848 by 848 pixels. Davis DR grading. No pharmacologic dilation. 45° field of view — 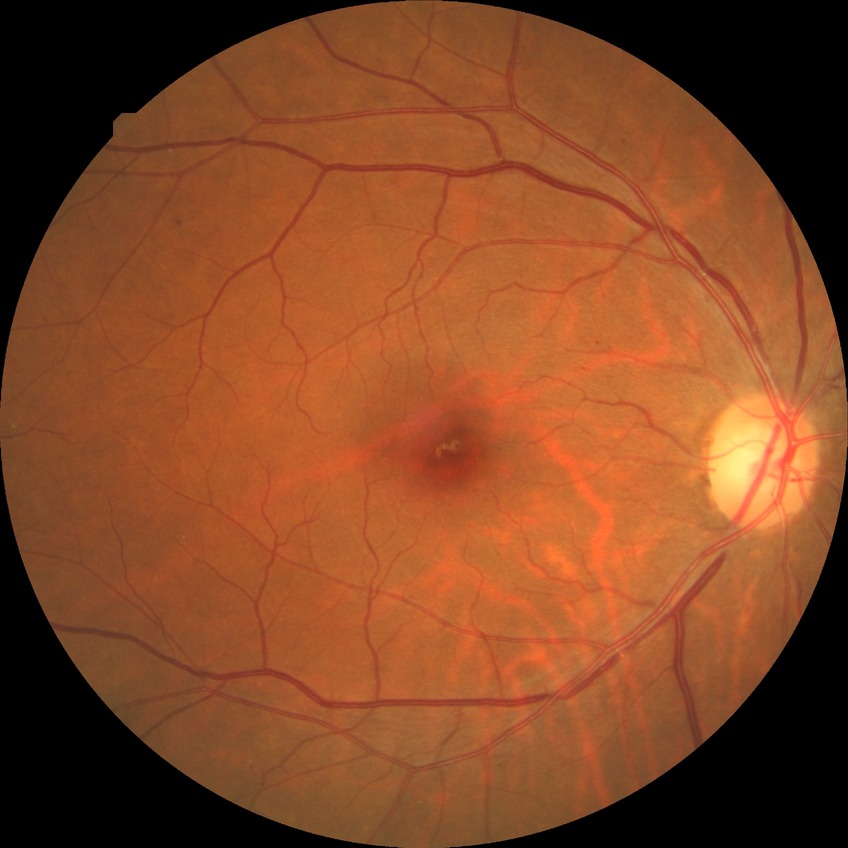
Modified Davis grading: simple diabetic retinopathy.